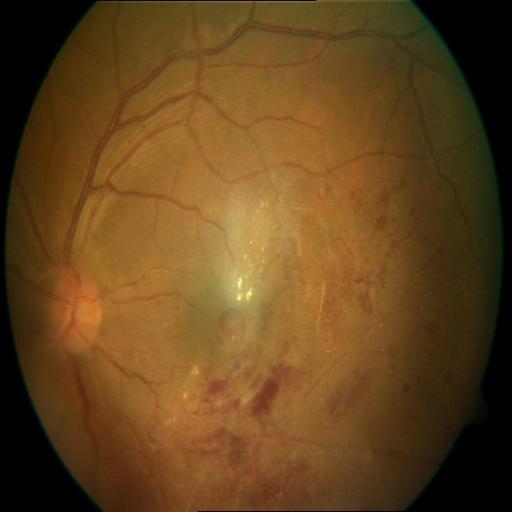 The image shows branch retinal vein occlusion (BRVO).